CFP. 1659 x 2212 pixels. Camera: Remidio Fundus on Phone (FOP) camera
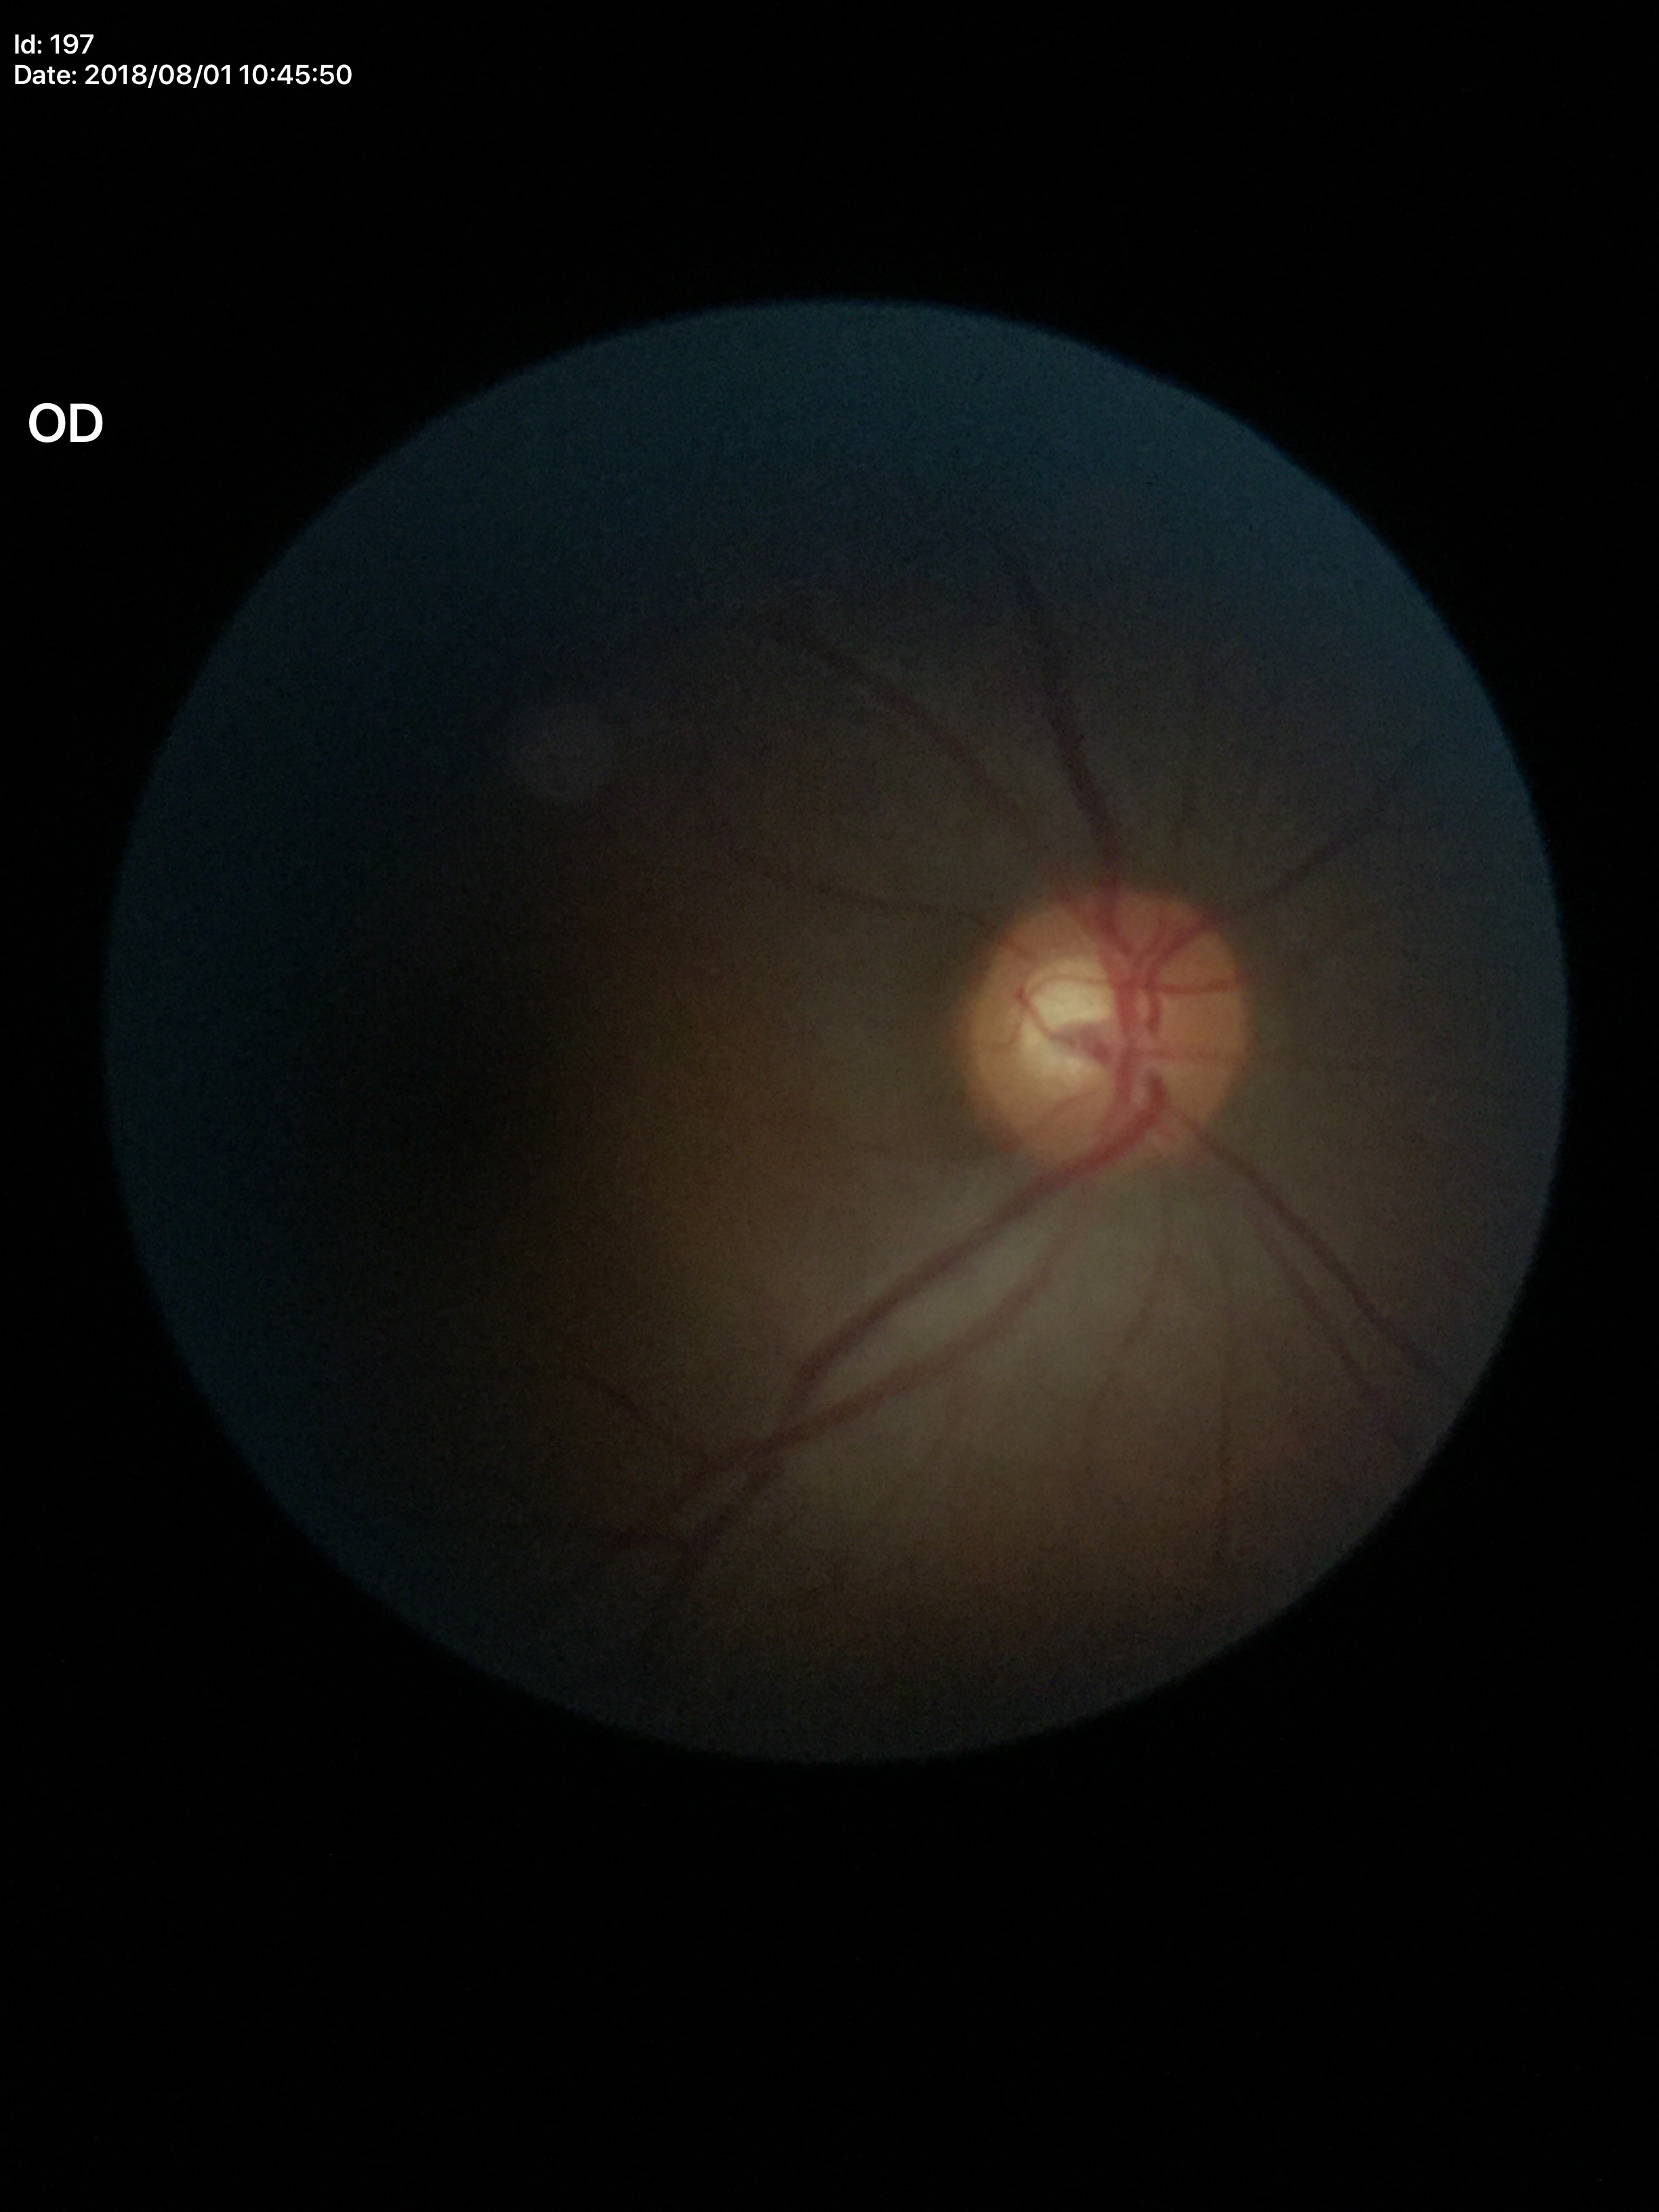

Negative for glaucoma suspicion. Vertical cup-to-disc ratio (VCDR) of 0.56.